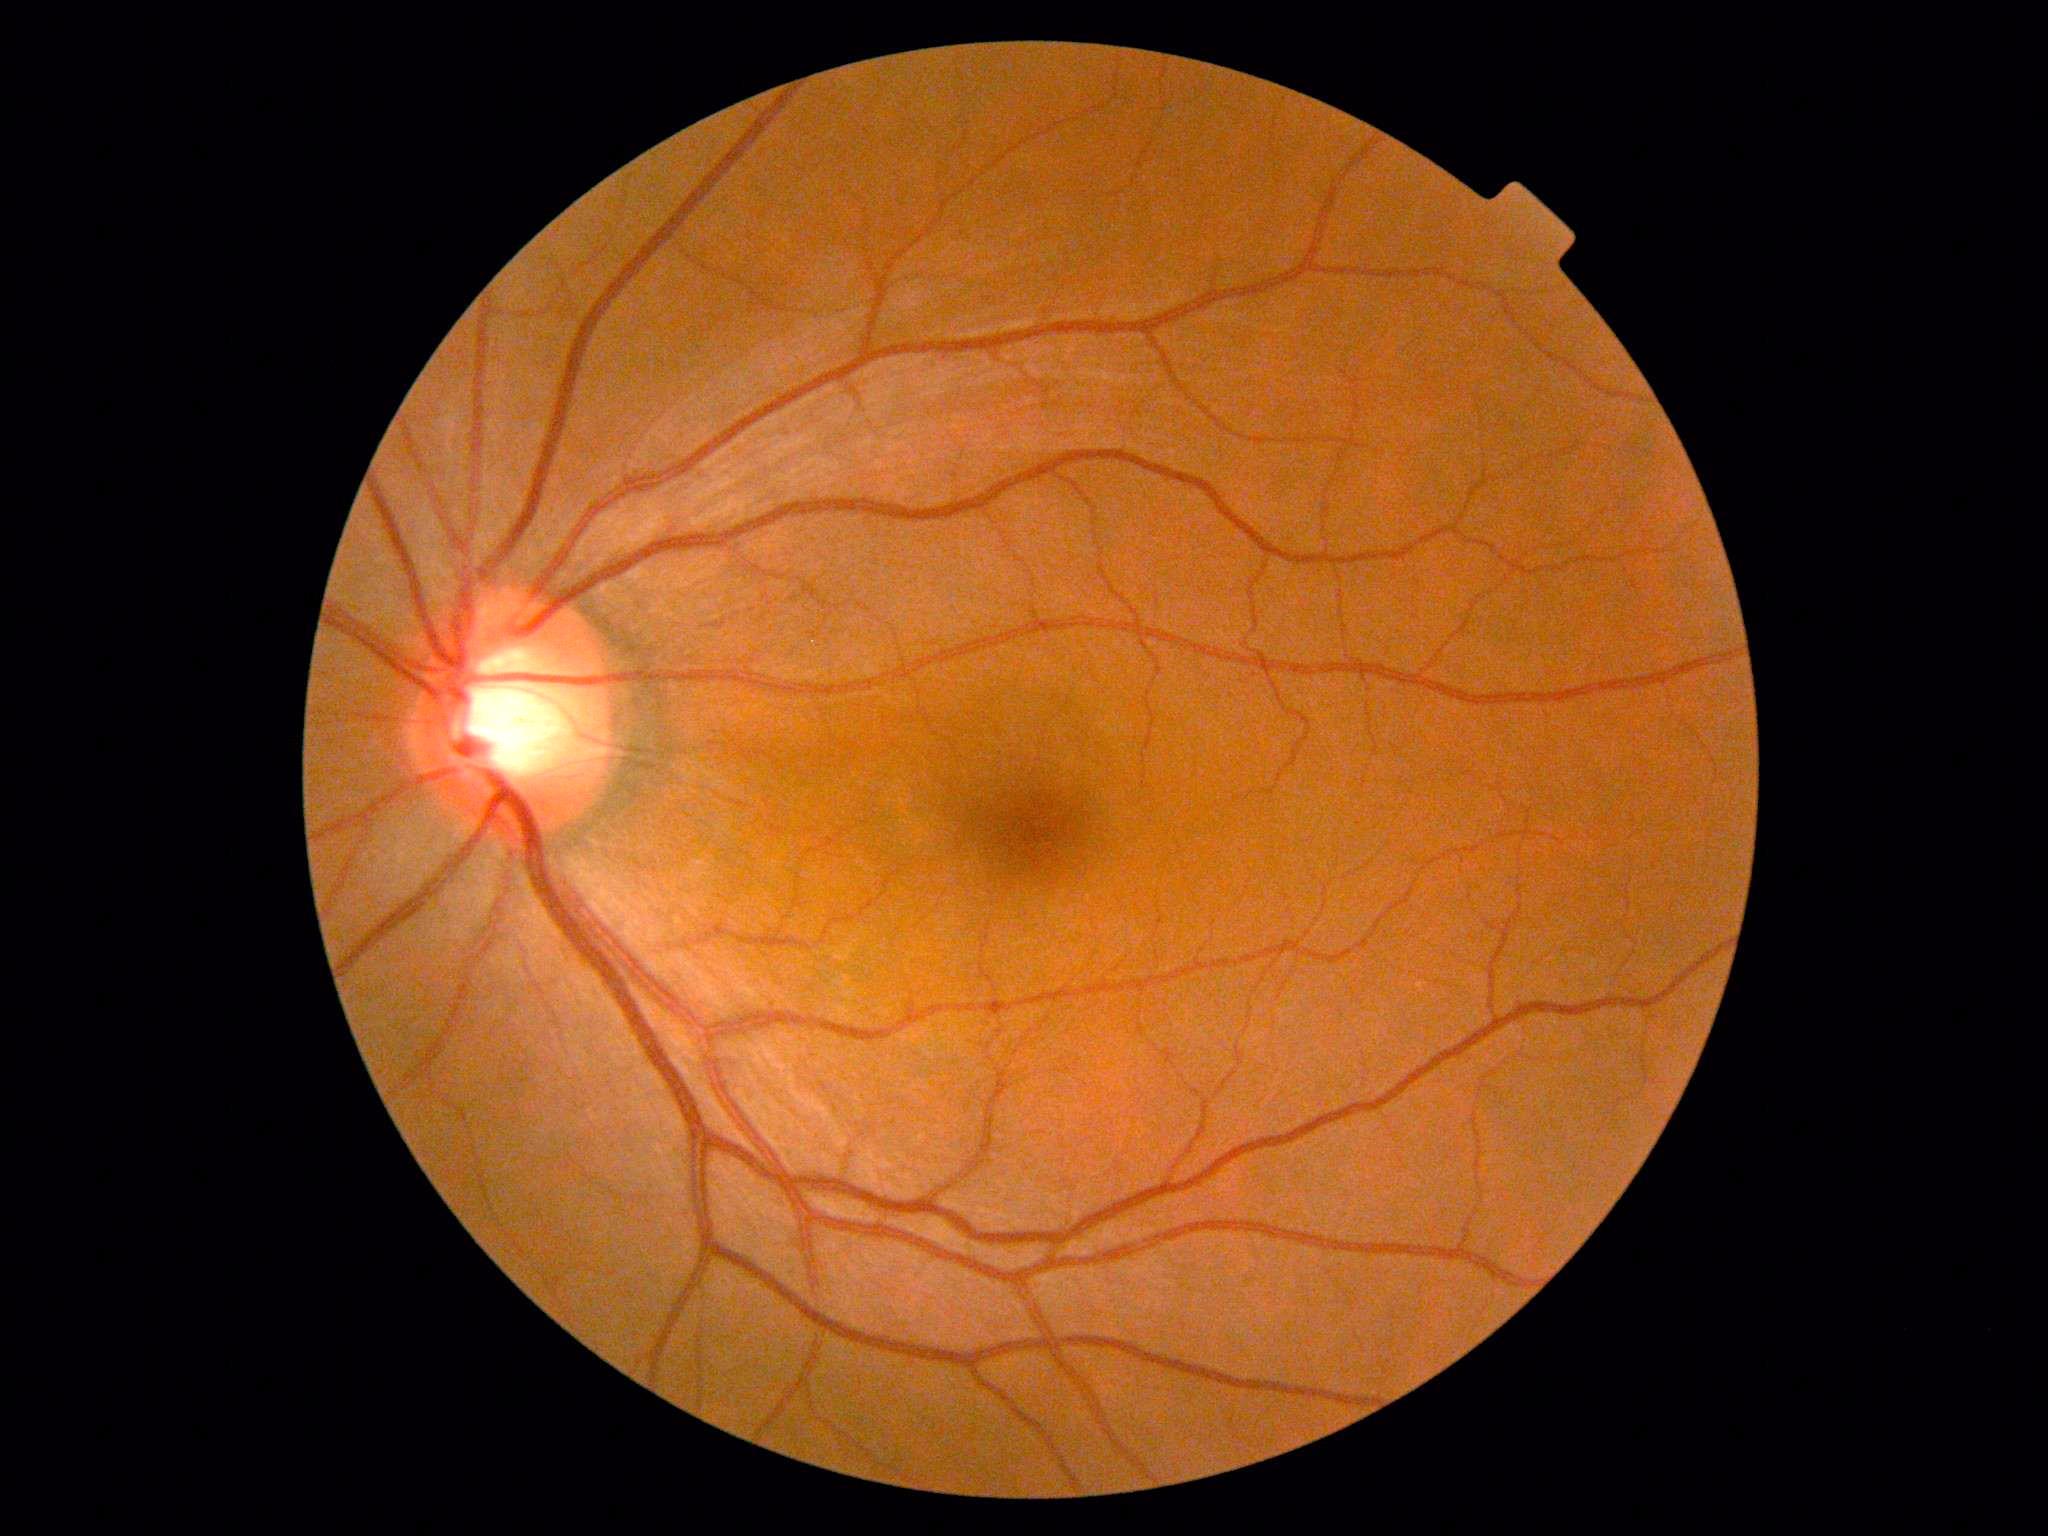

Diabetic retinopathy (DR) is 0.